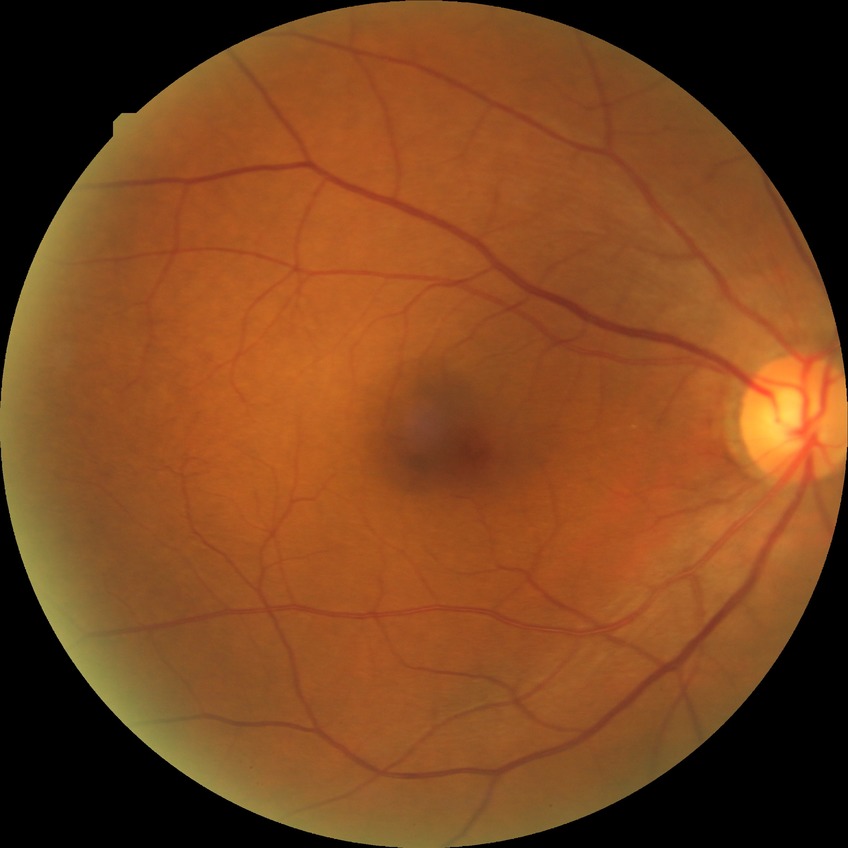

Diabetic retinopathy (DR) is simple diabetic retinopathy (SDR).